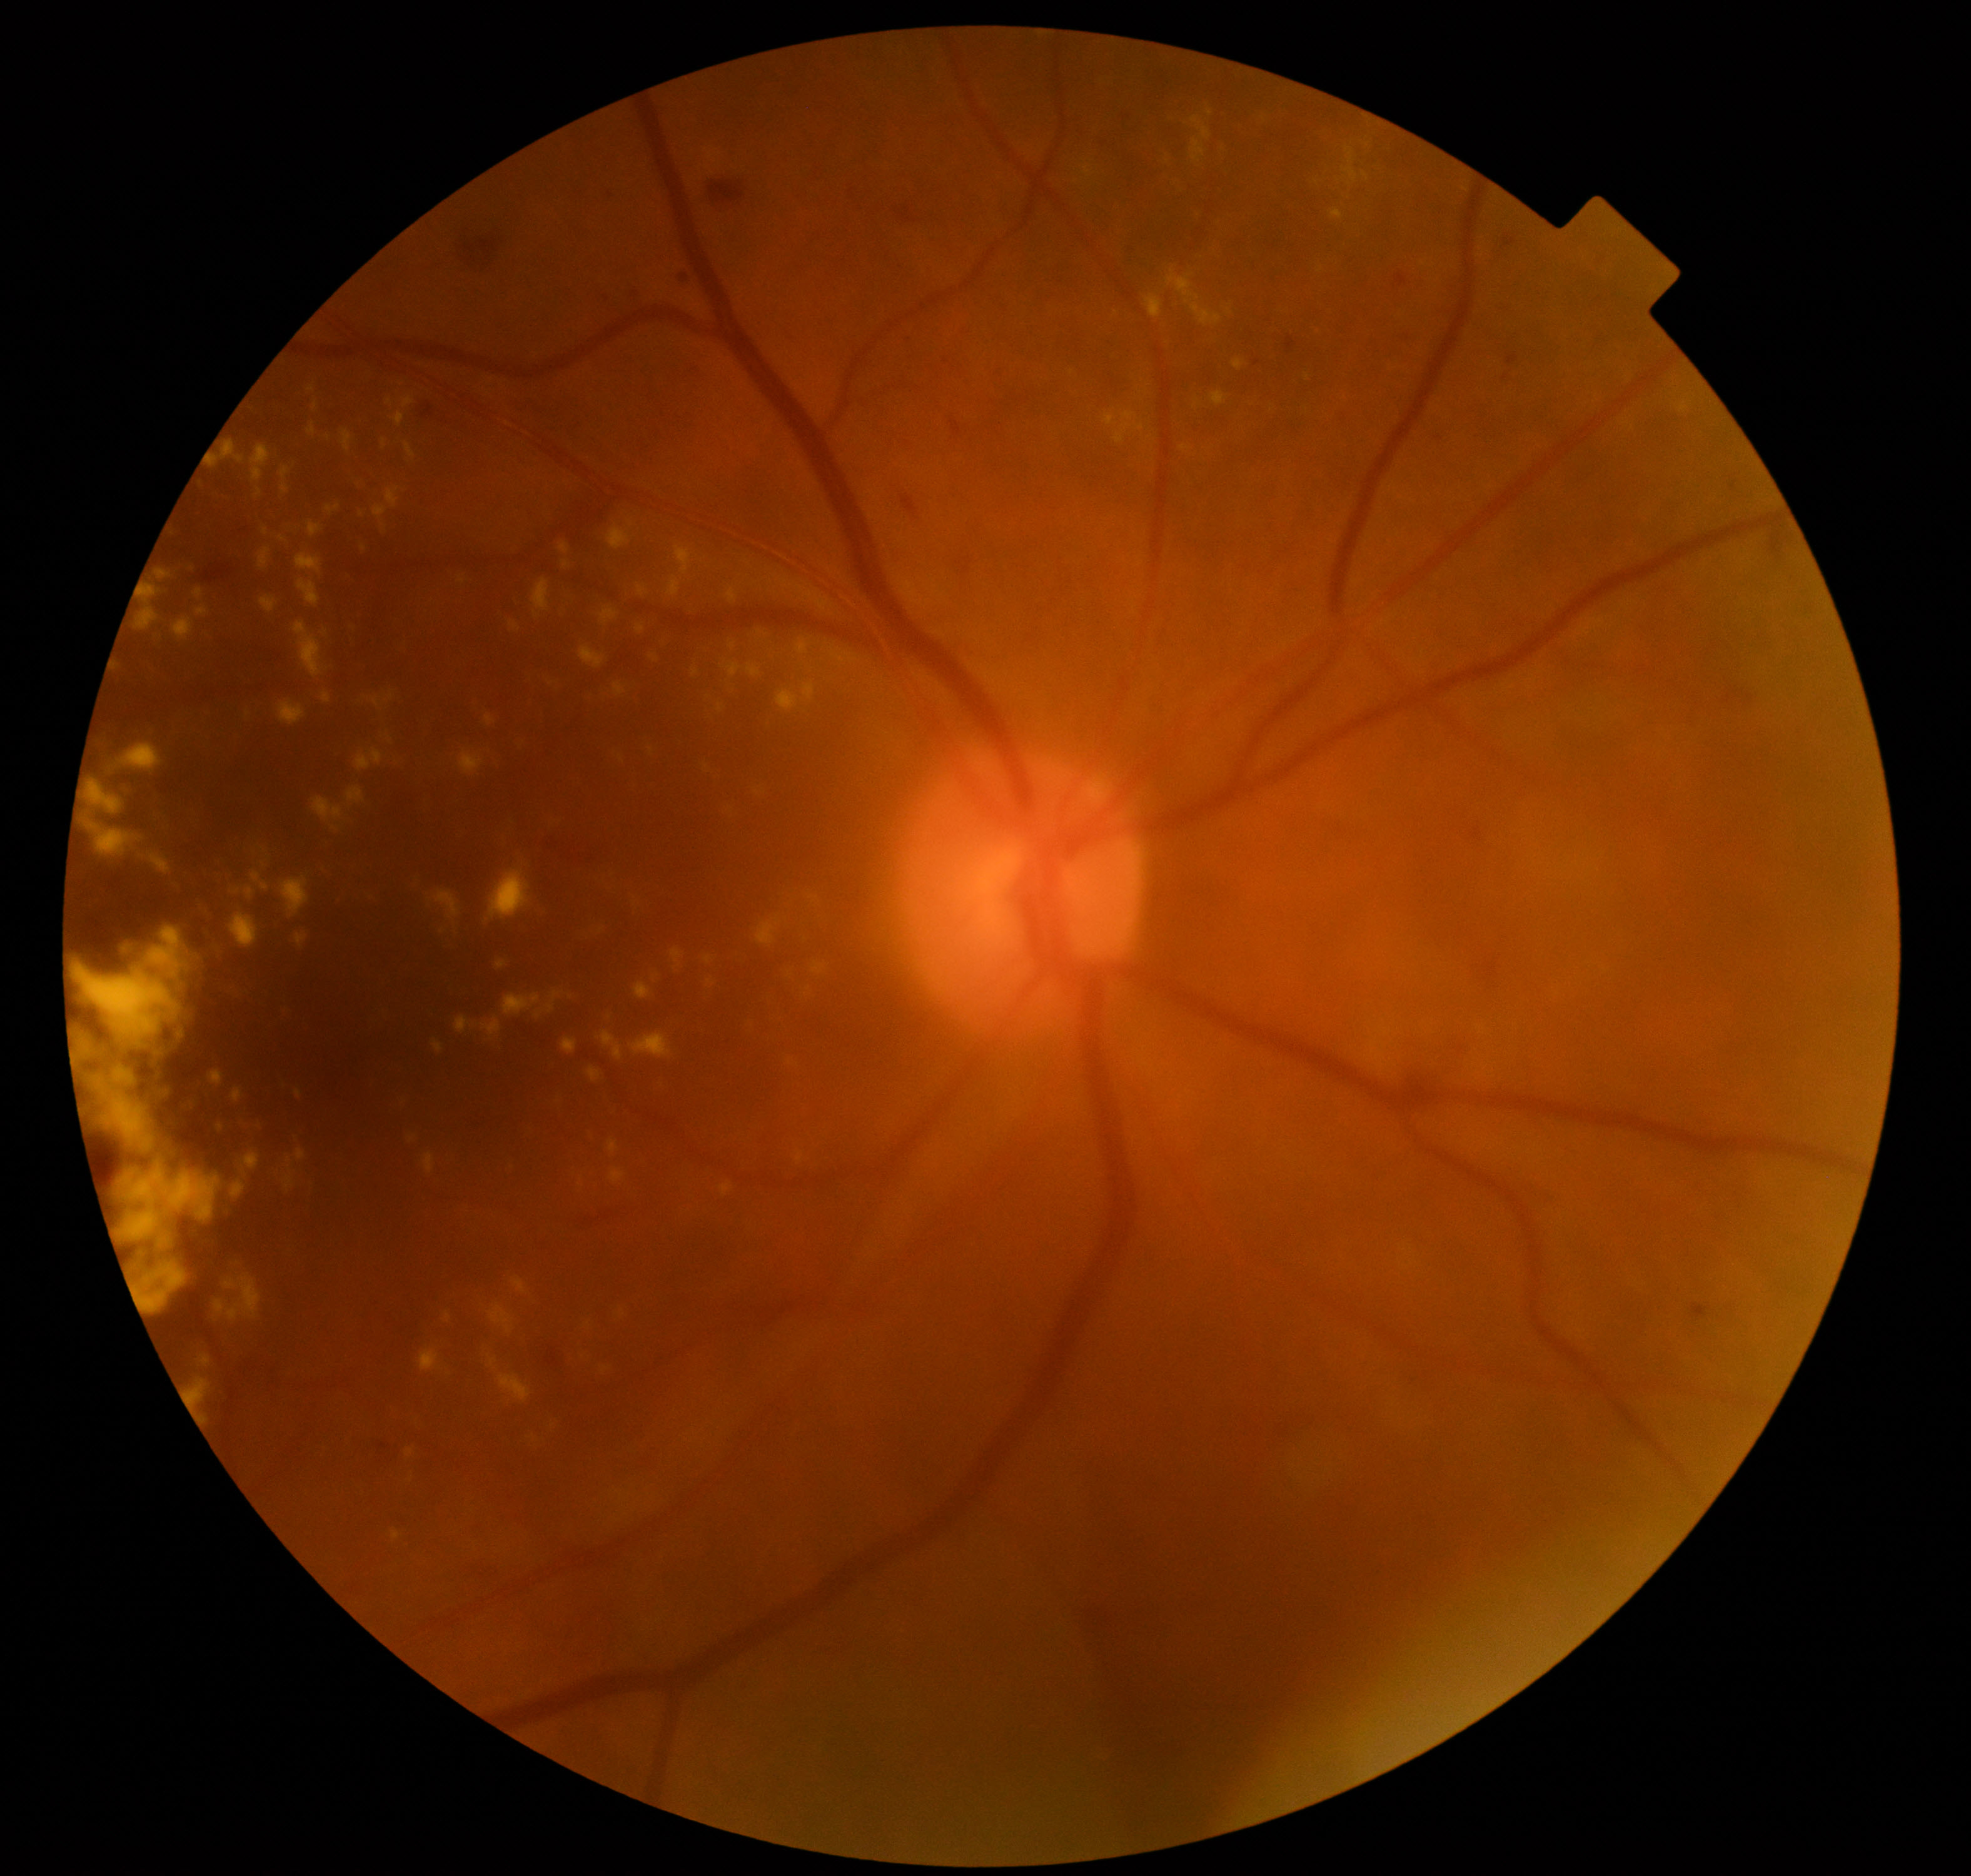 Primary finding: moderate non-proliferative diabetic retinopathy.